1725 by 1721 pixels, color fundus photograph:
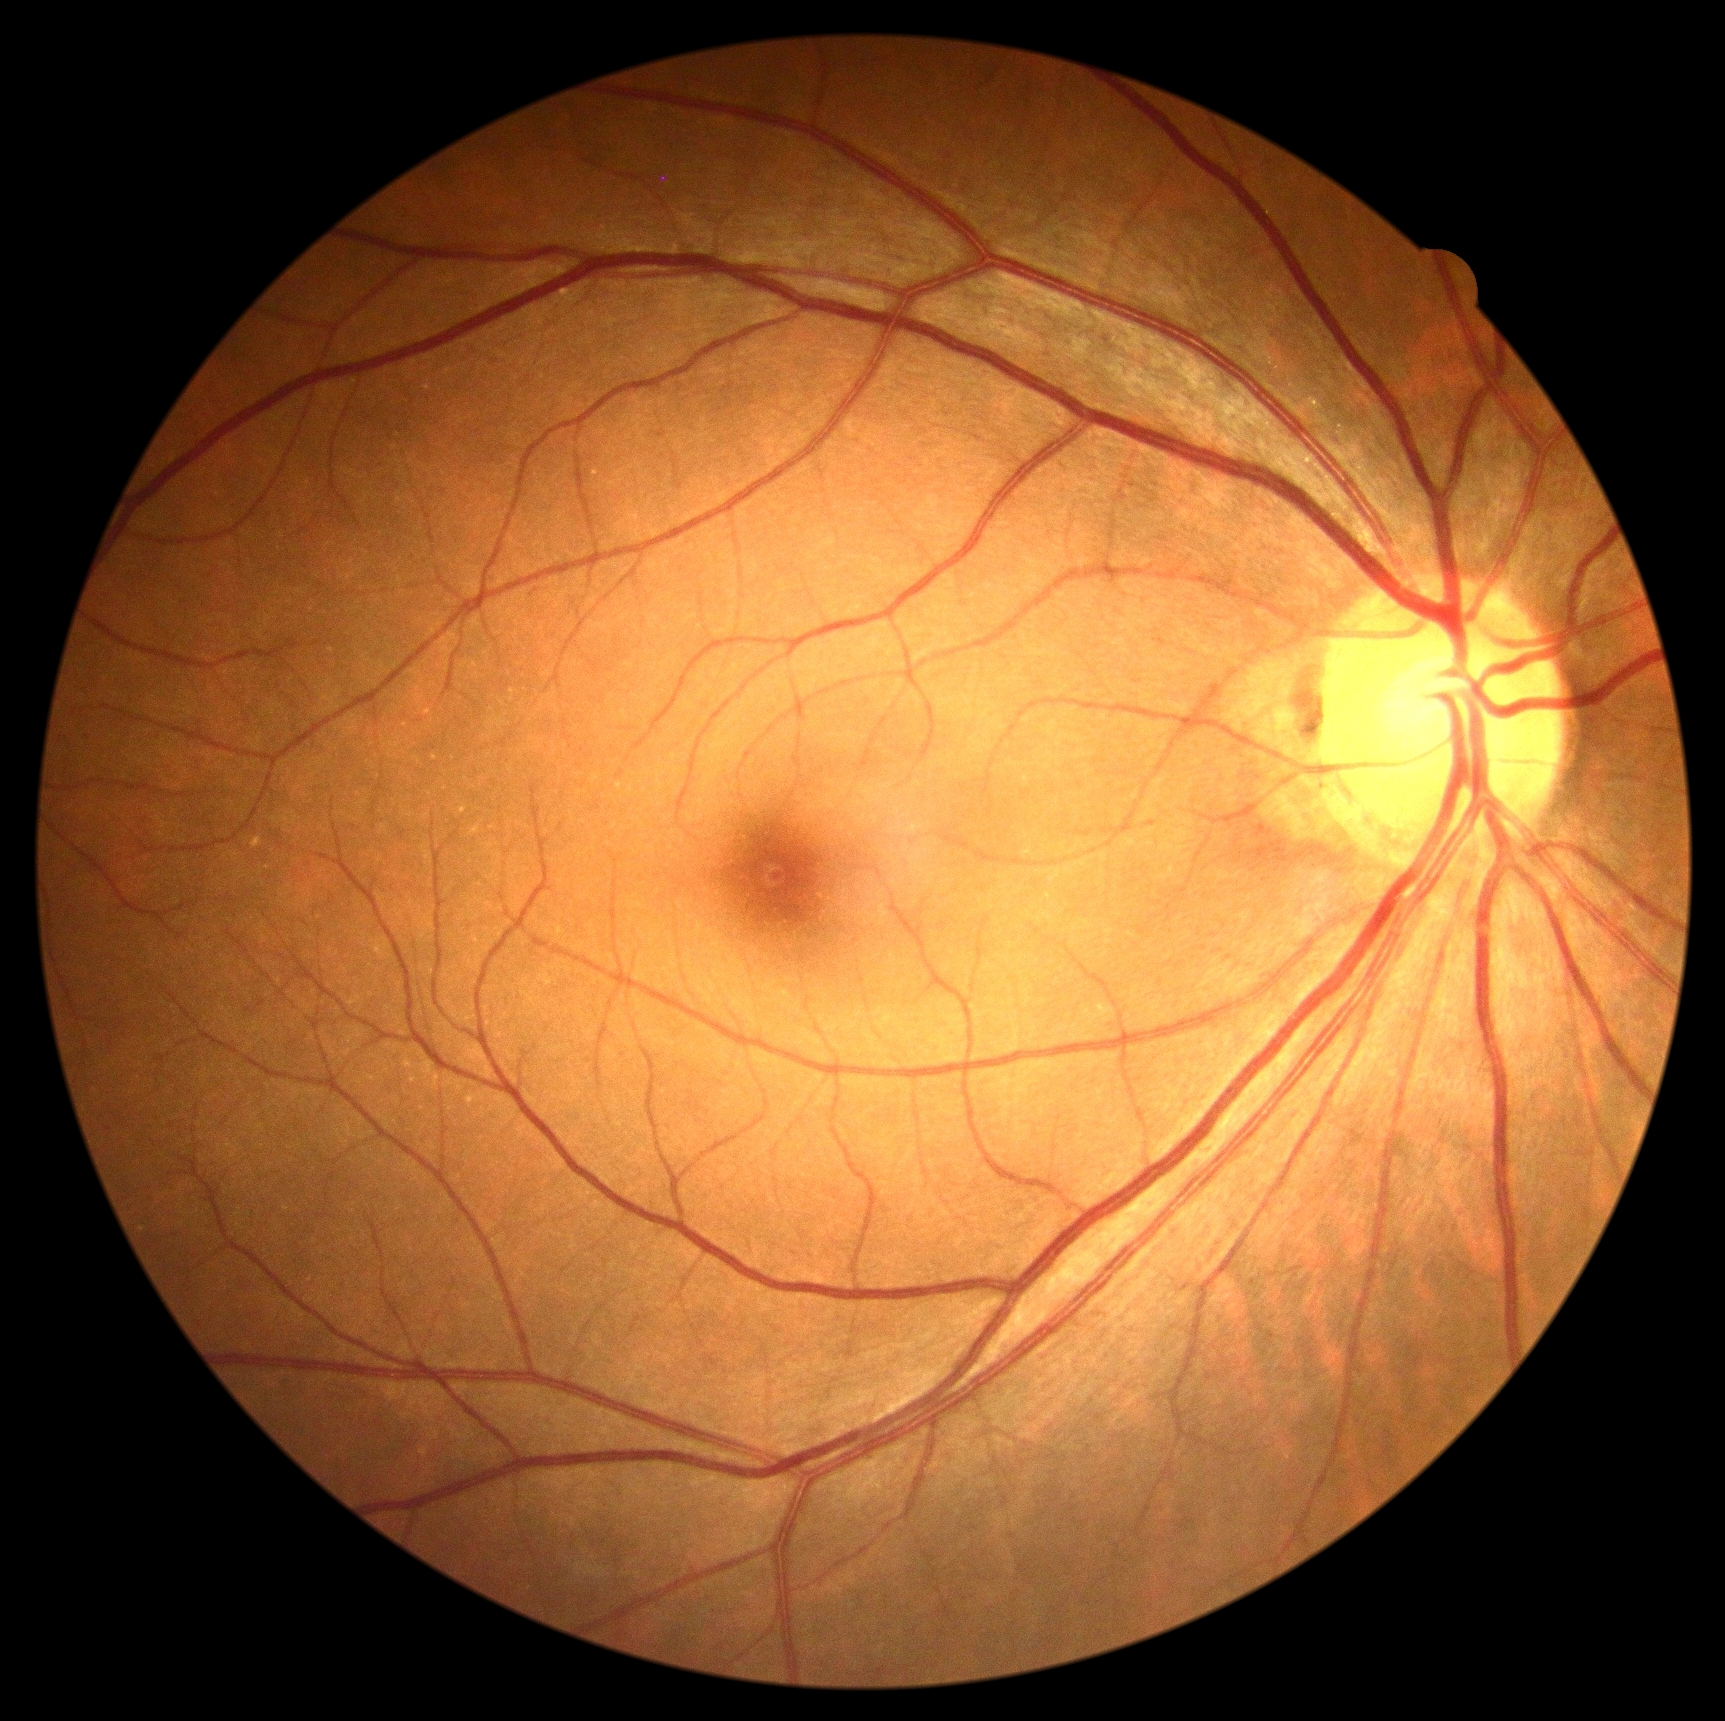
{"dr_impression": "negative for DR", "dr_grade": "grade 0"}